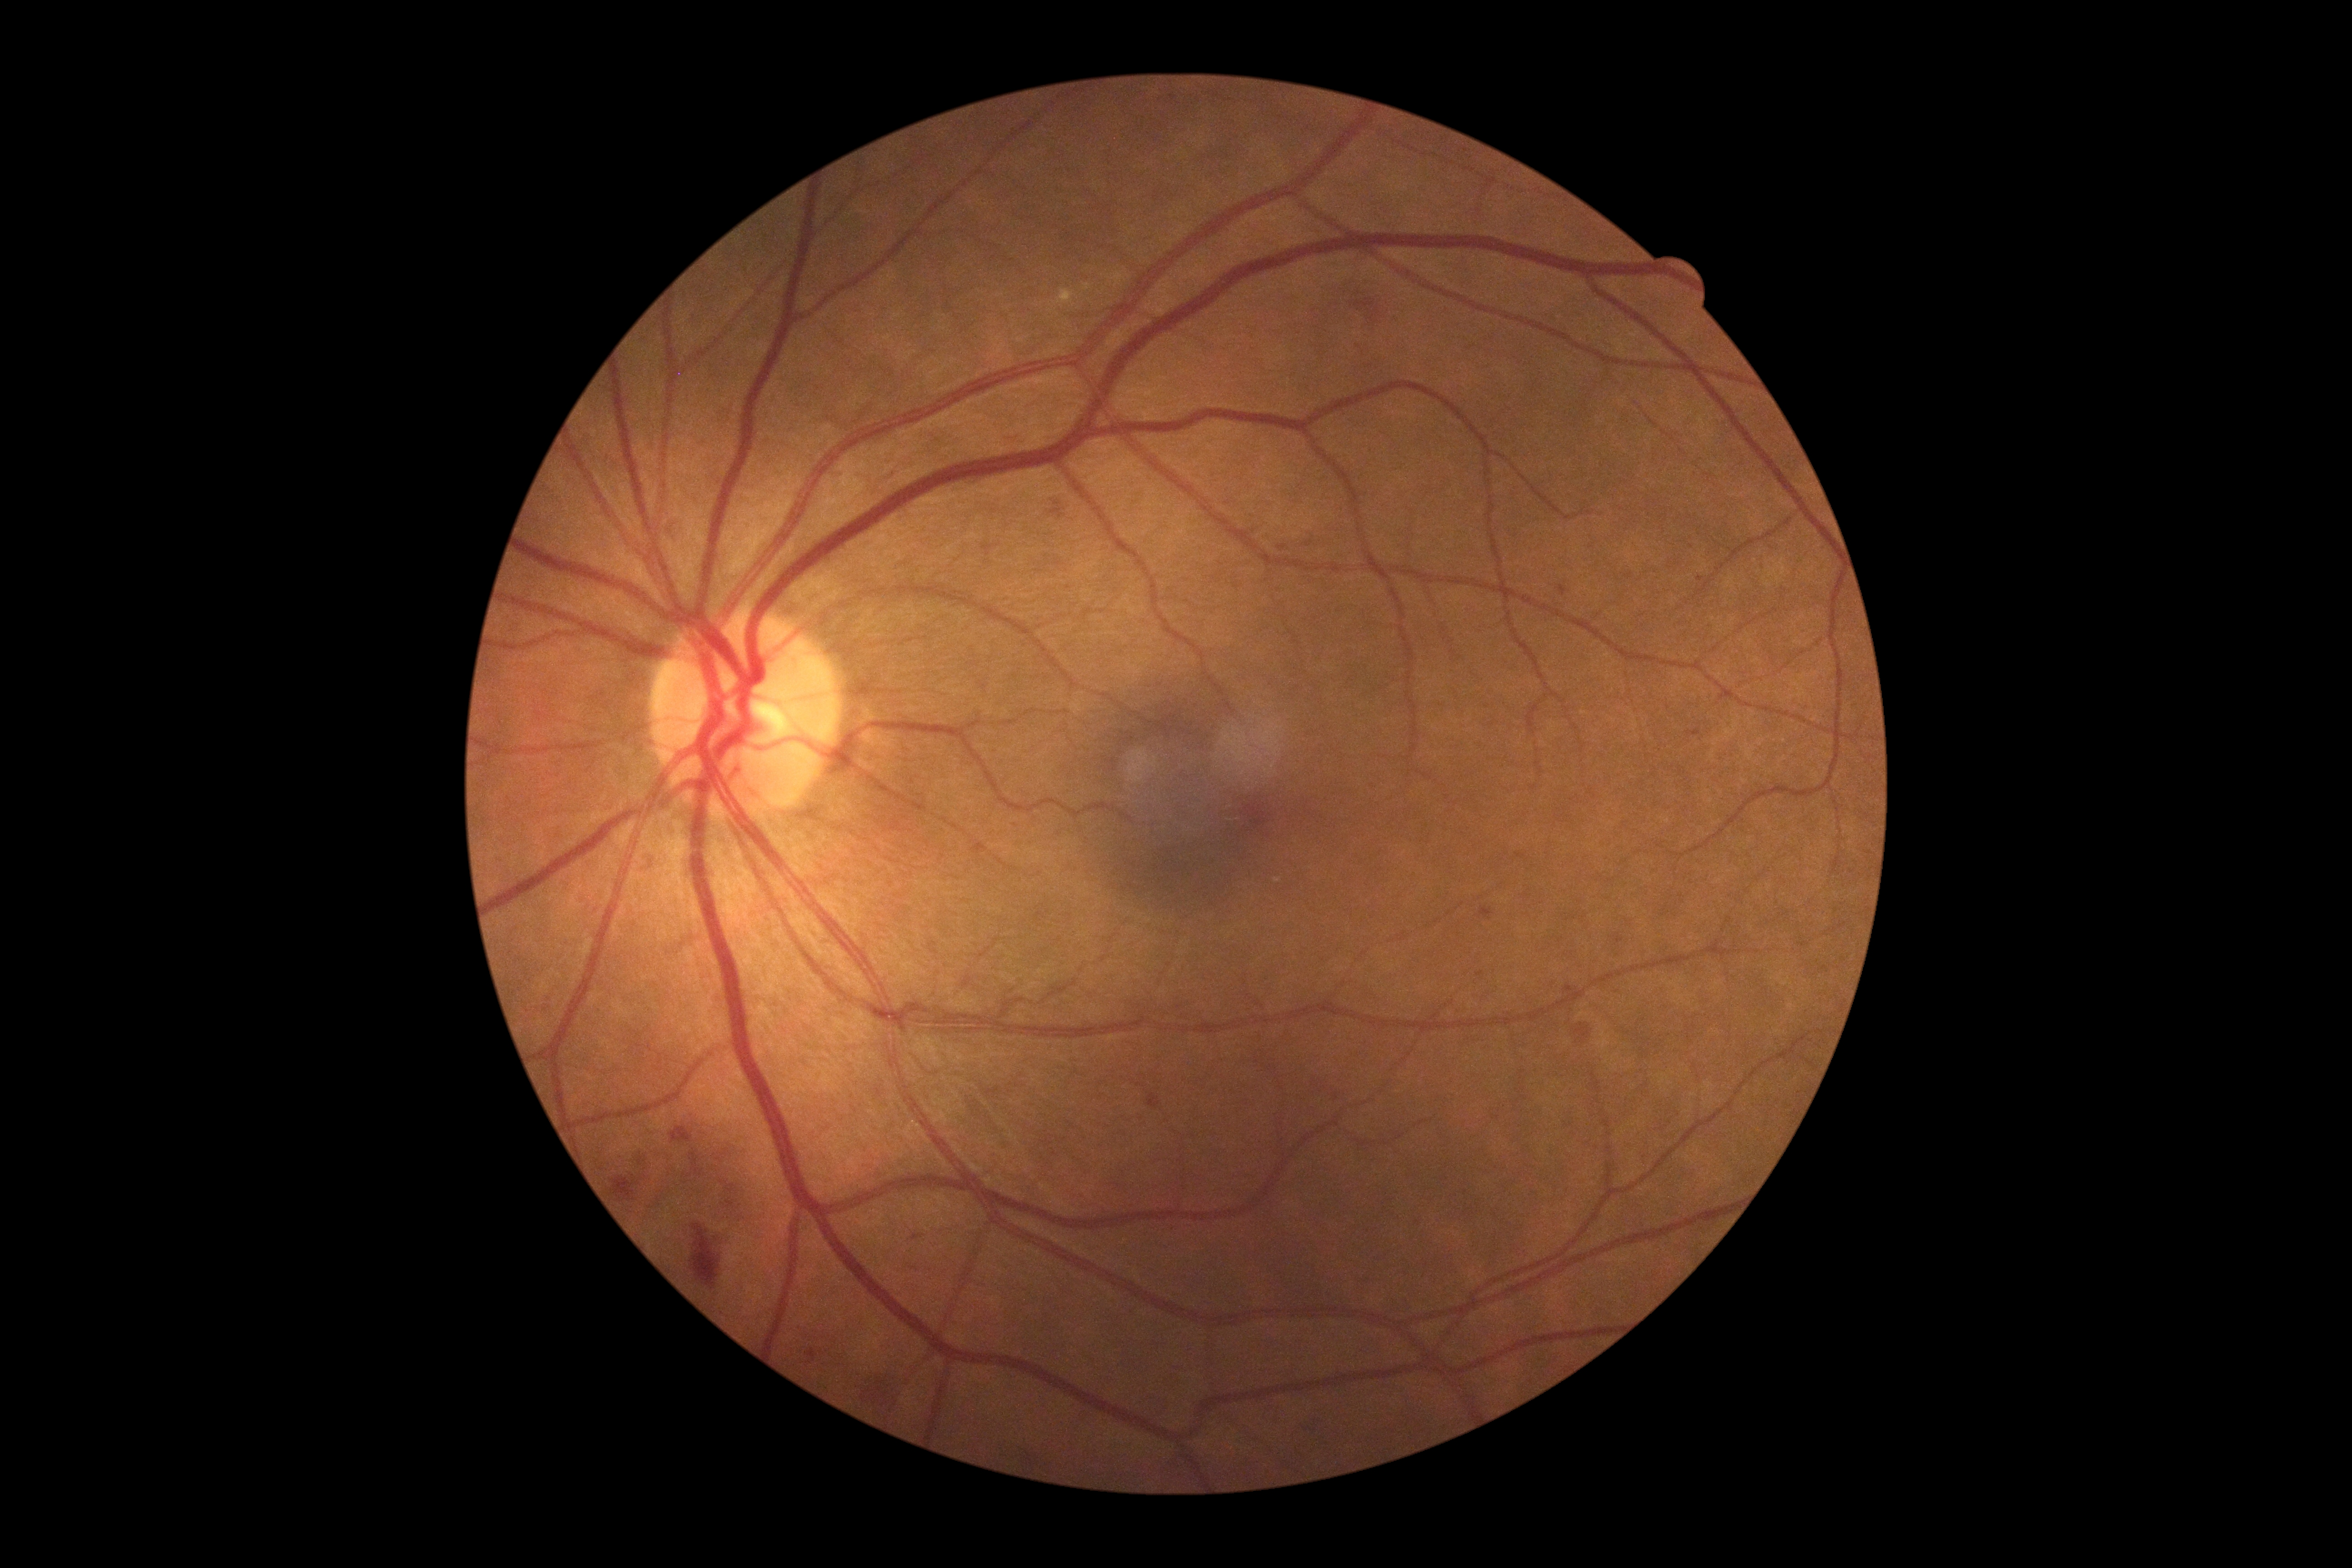

DR grade: moderate NPDR (2).